Acquired on the Clarity RetCam 3; wide-field fundus photograph from neonatal ROP screening.
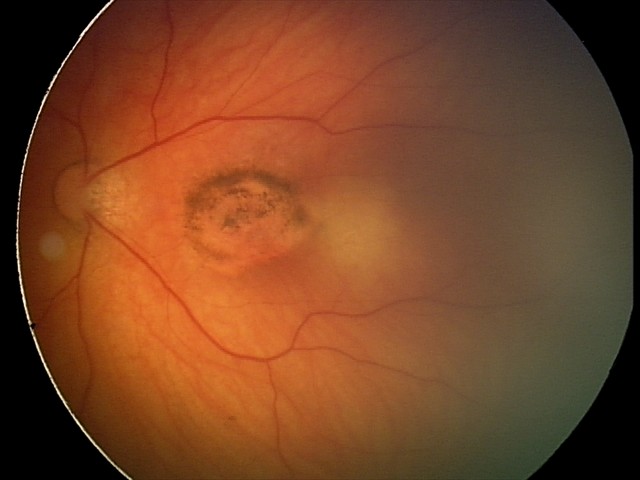

Impression: toxoplasmosis chorioretinitis.